CFP.
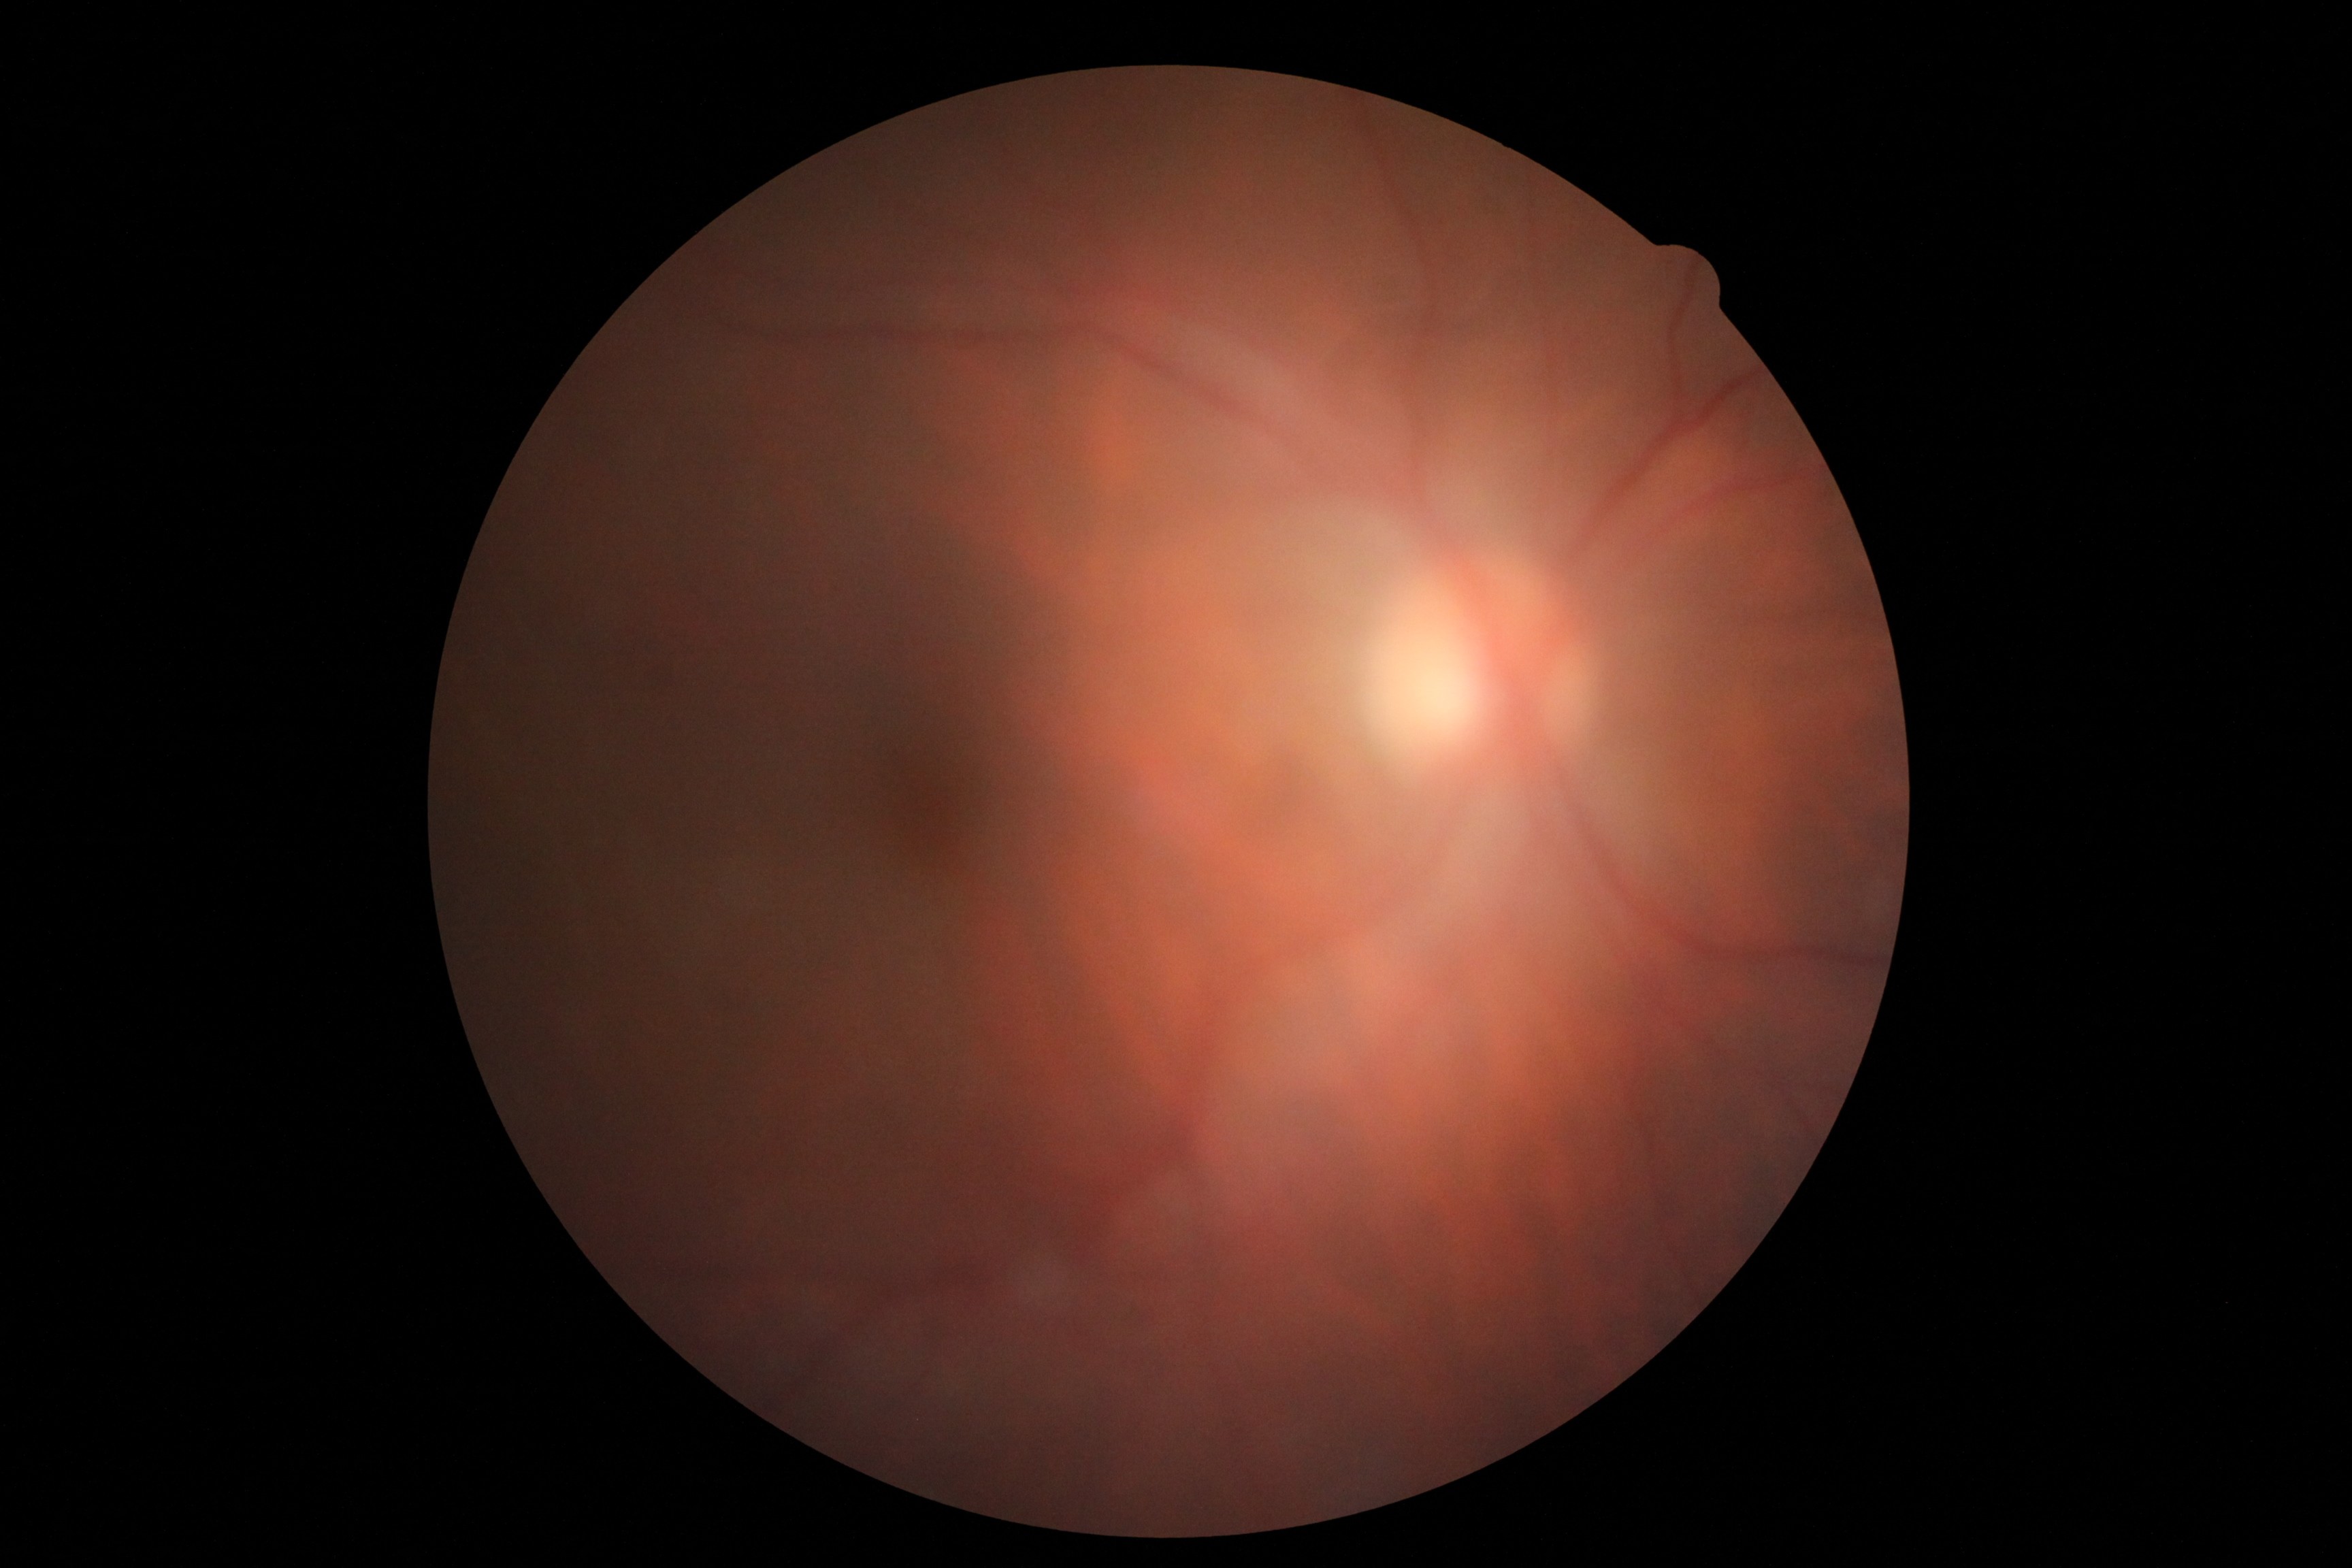
Diabetic retinopathy (DR) is 0/4.